Pediatric retinal photograph (wide-field):
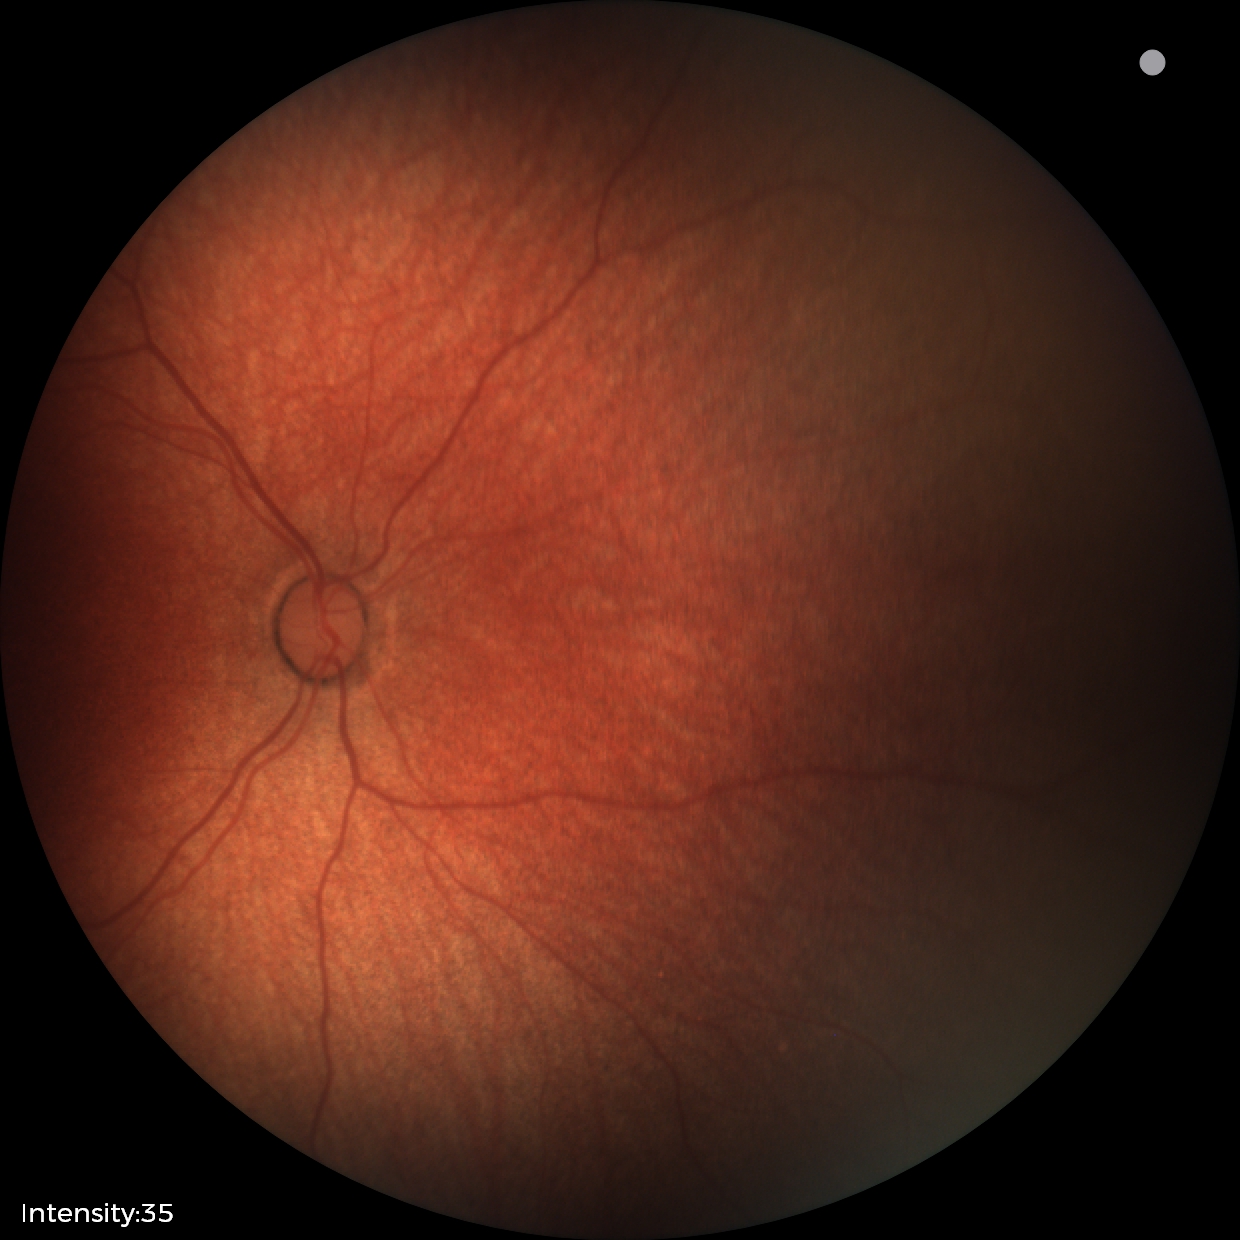
Finding = no pathology identified.